2352x1568
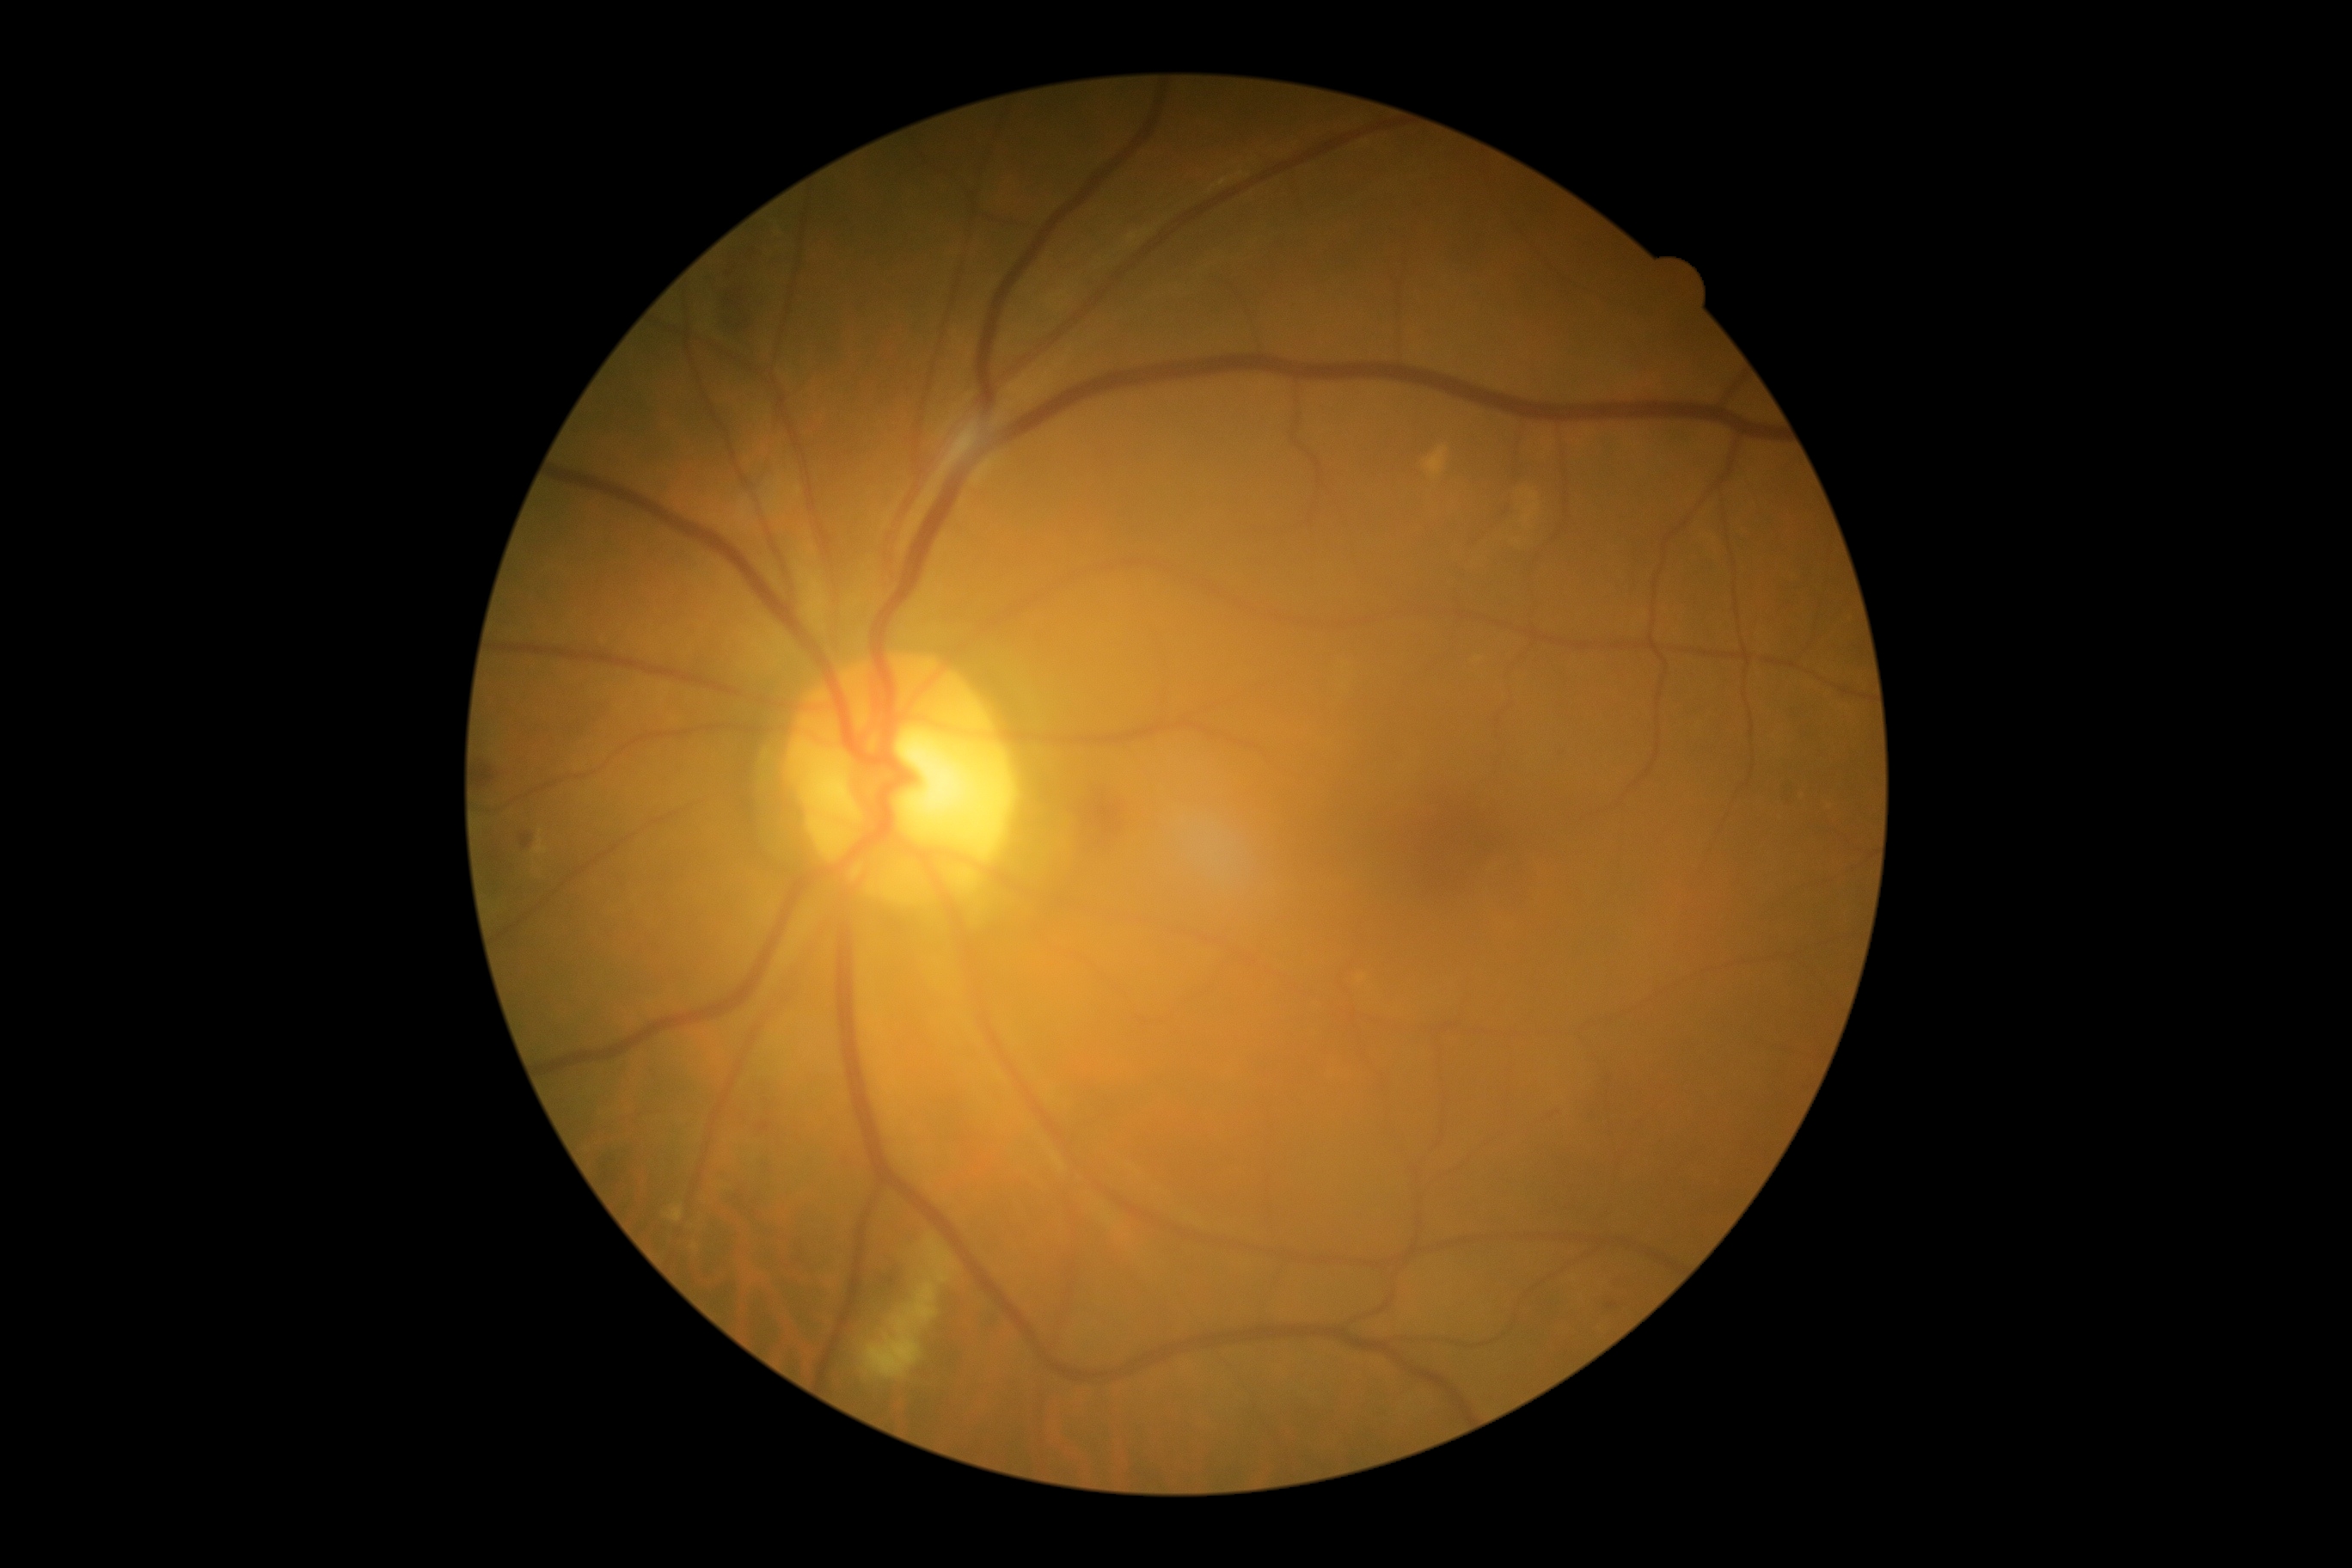
The retinopathy is classified as non-proliferative diabetic retinopathy.
DR grade is 2 (moderate NPDR).